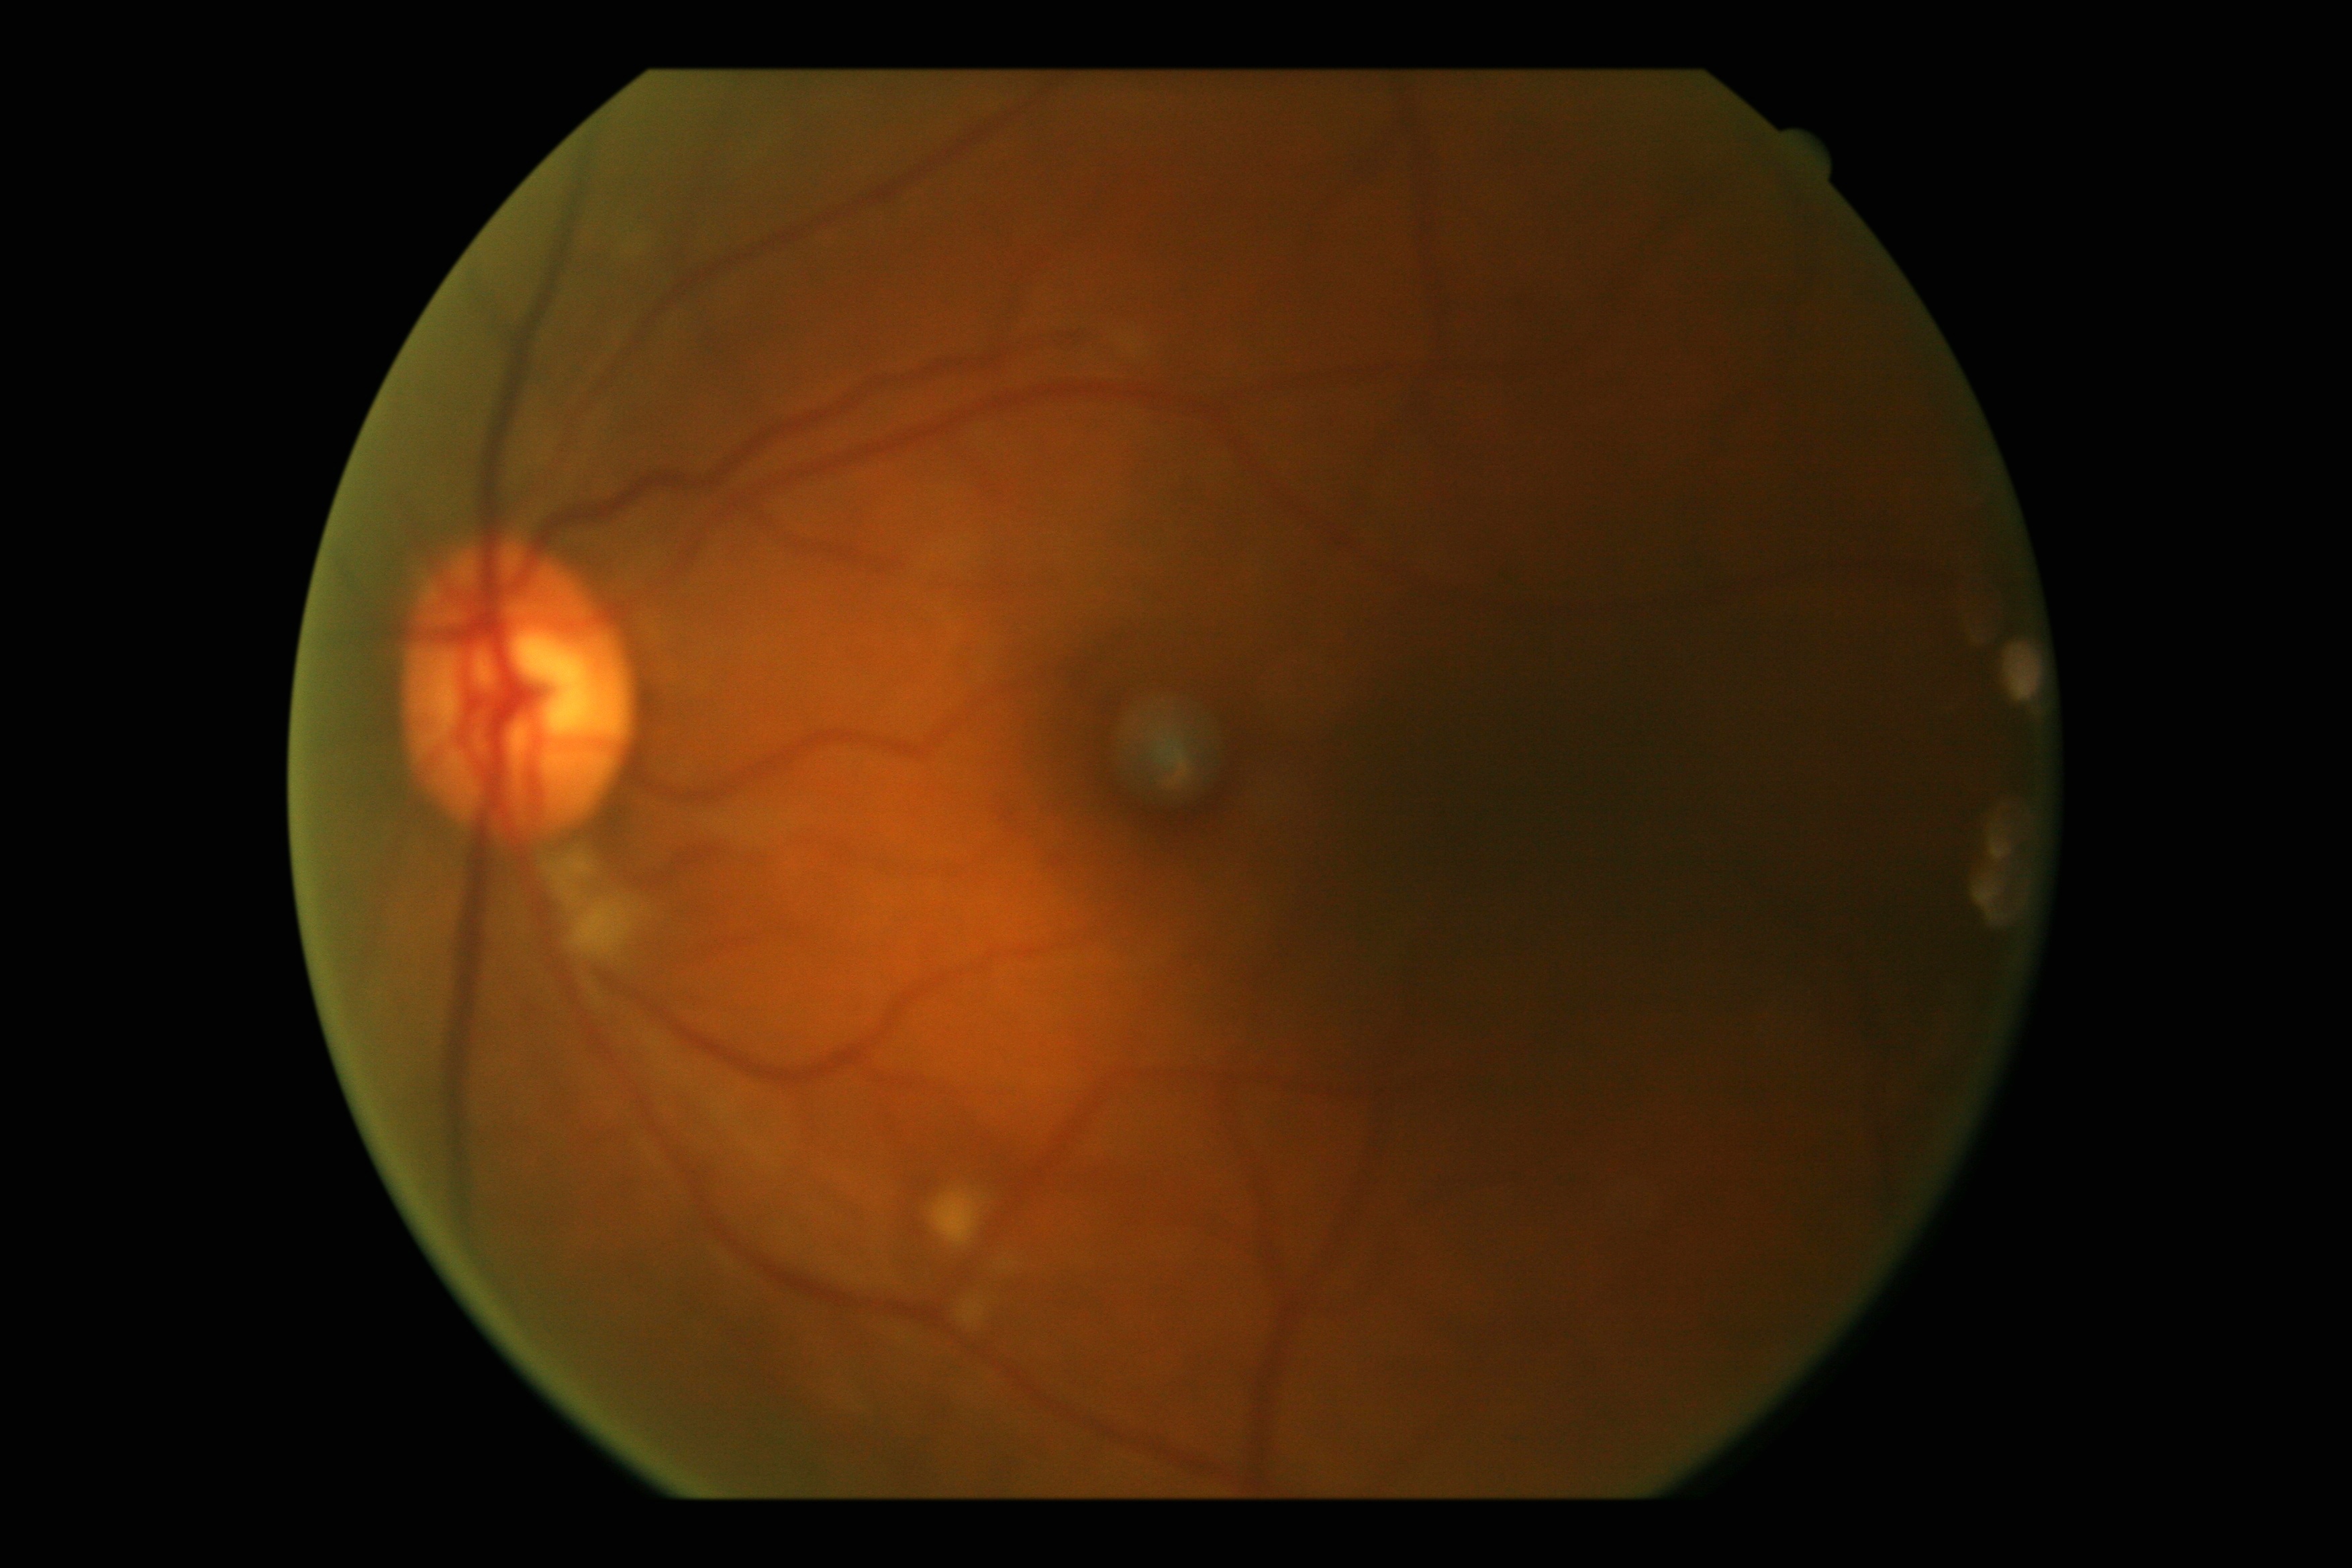 DR stage = grade 2 (moderate NPDR) — more than just microaneurysms but less than severe NPDR, DR class = non-proliferative diabetic retinopathy.